Modified Davis grading. 45° FOV. NIDEK AFC-230 fundus camera.
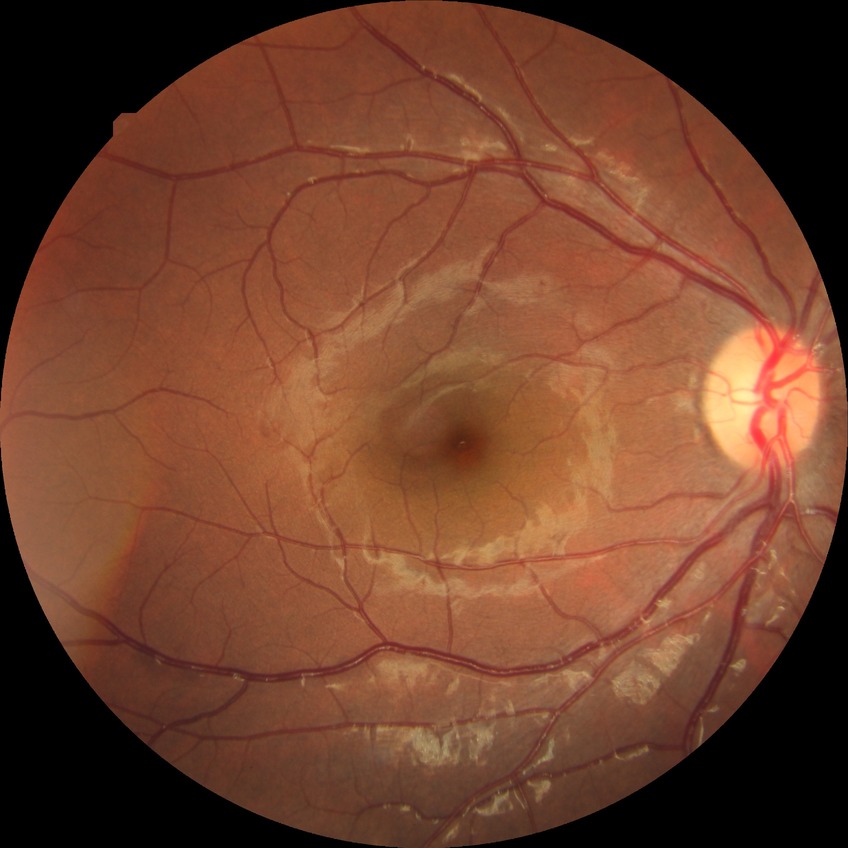 DR severity: SDR.